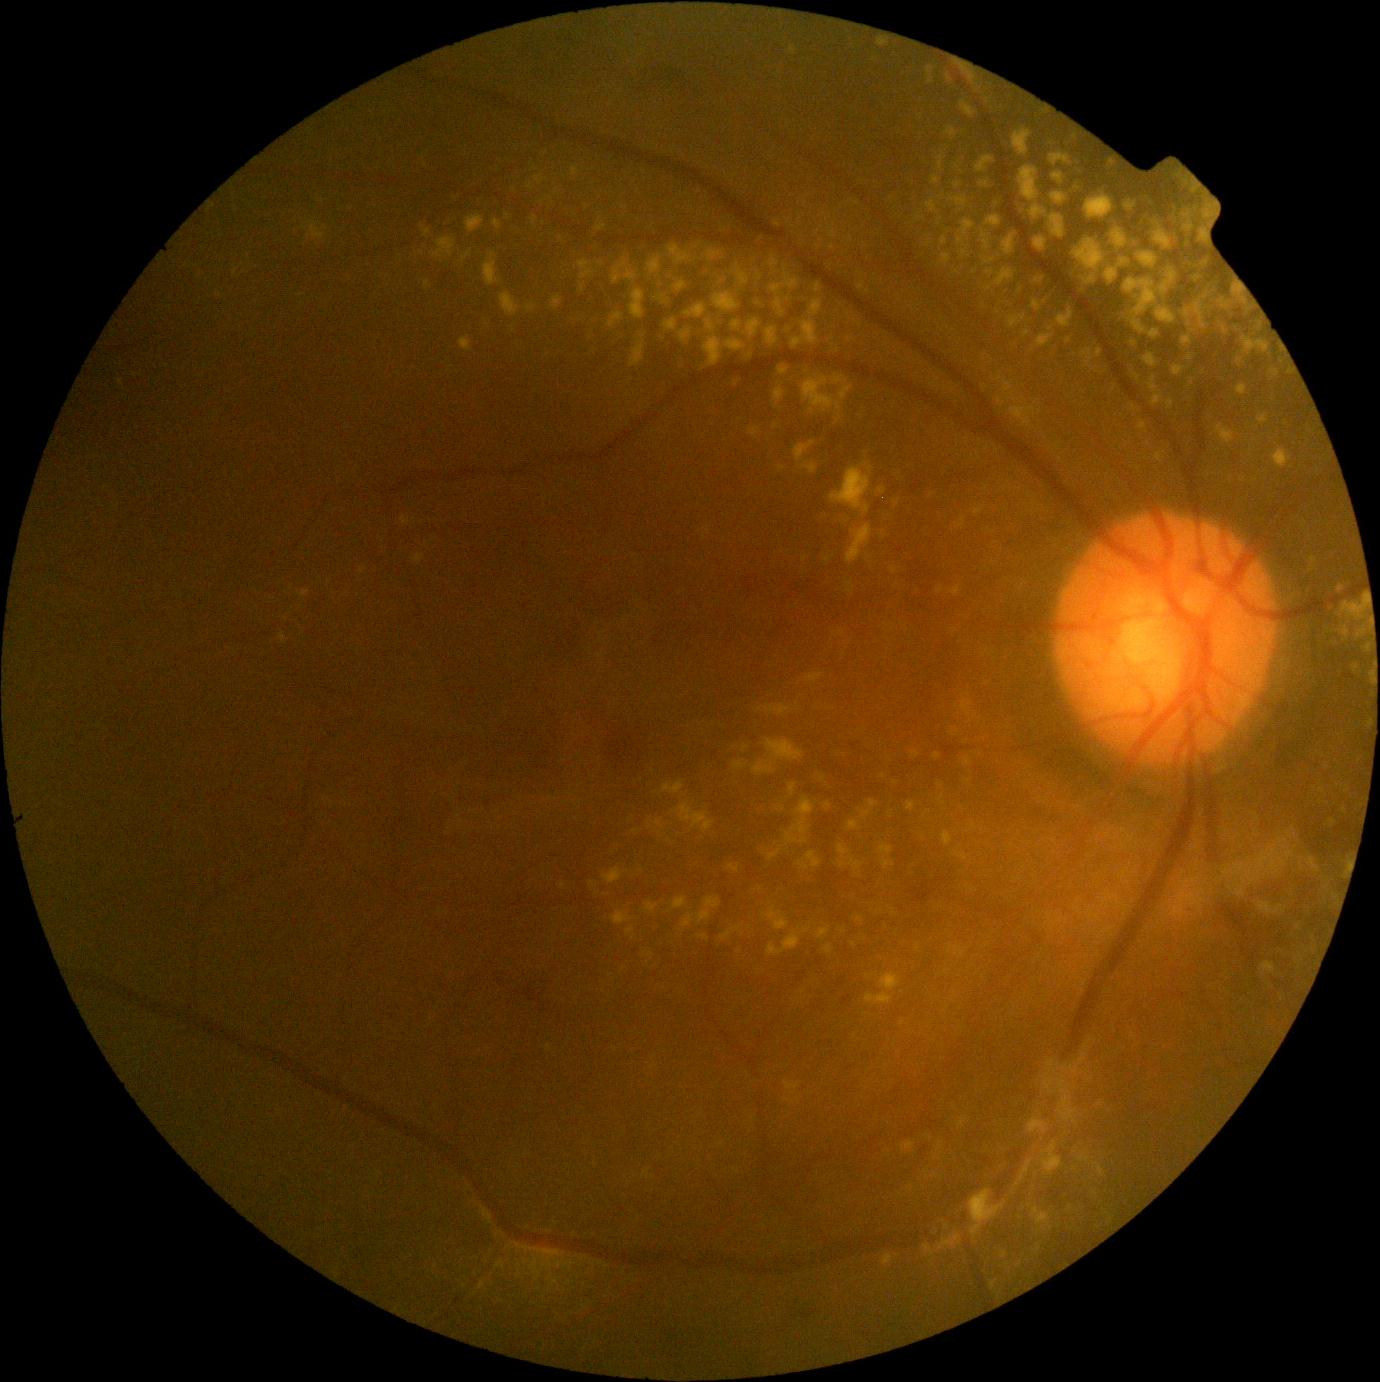
DR stage is moderate NPDR (grade 2).